45-degree field of view
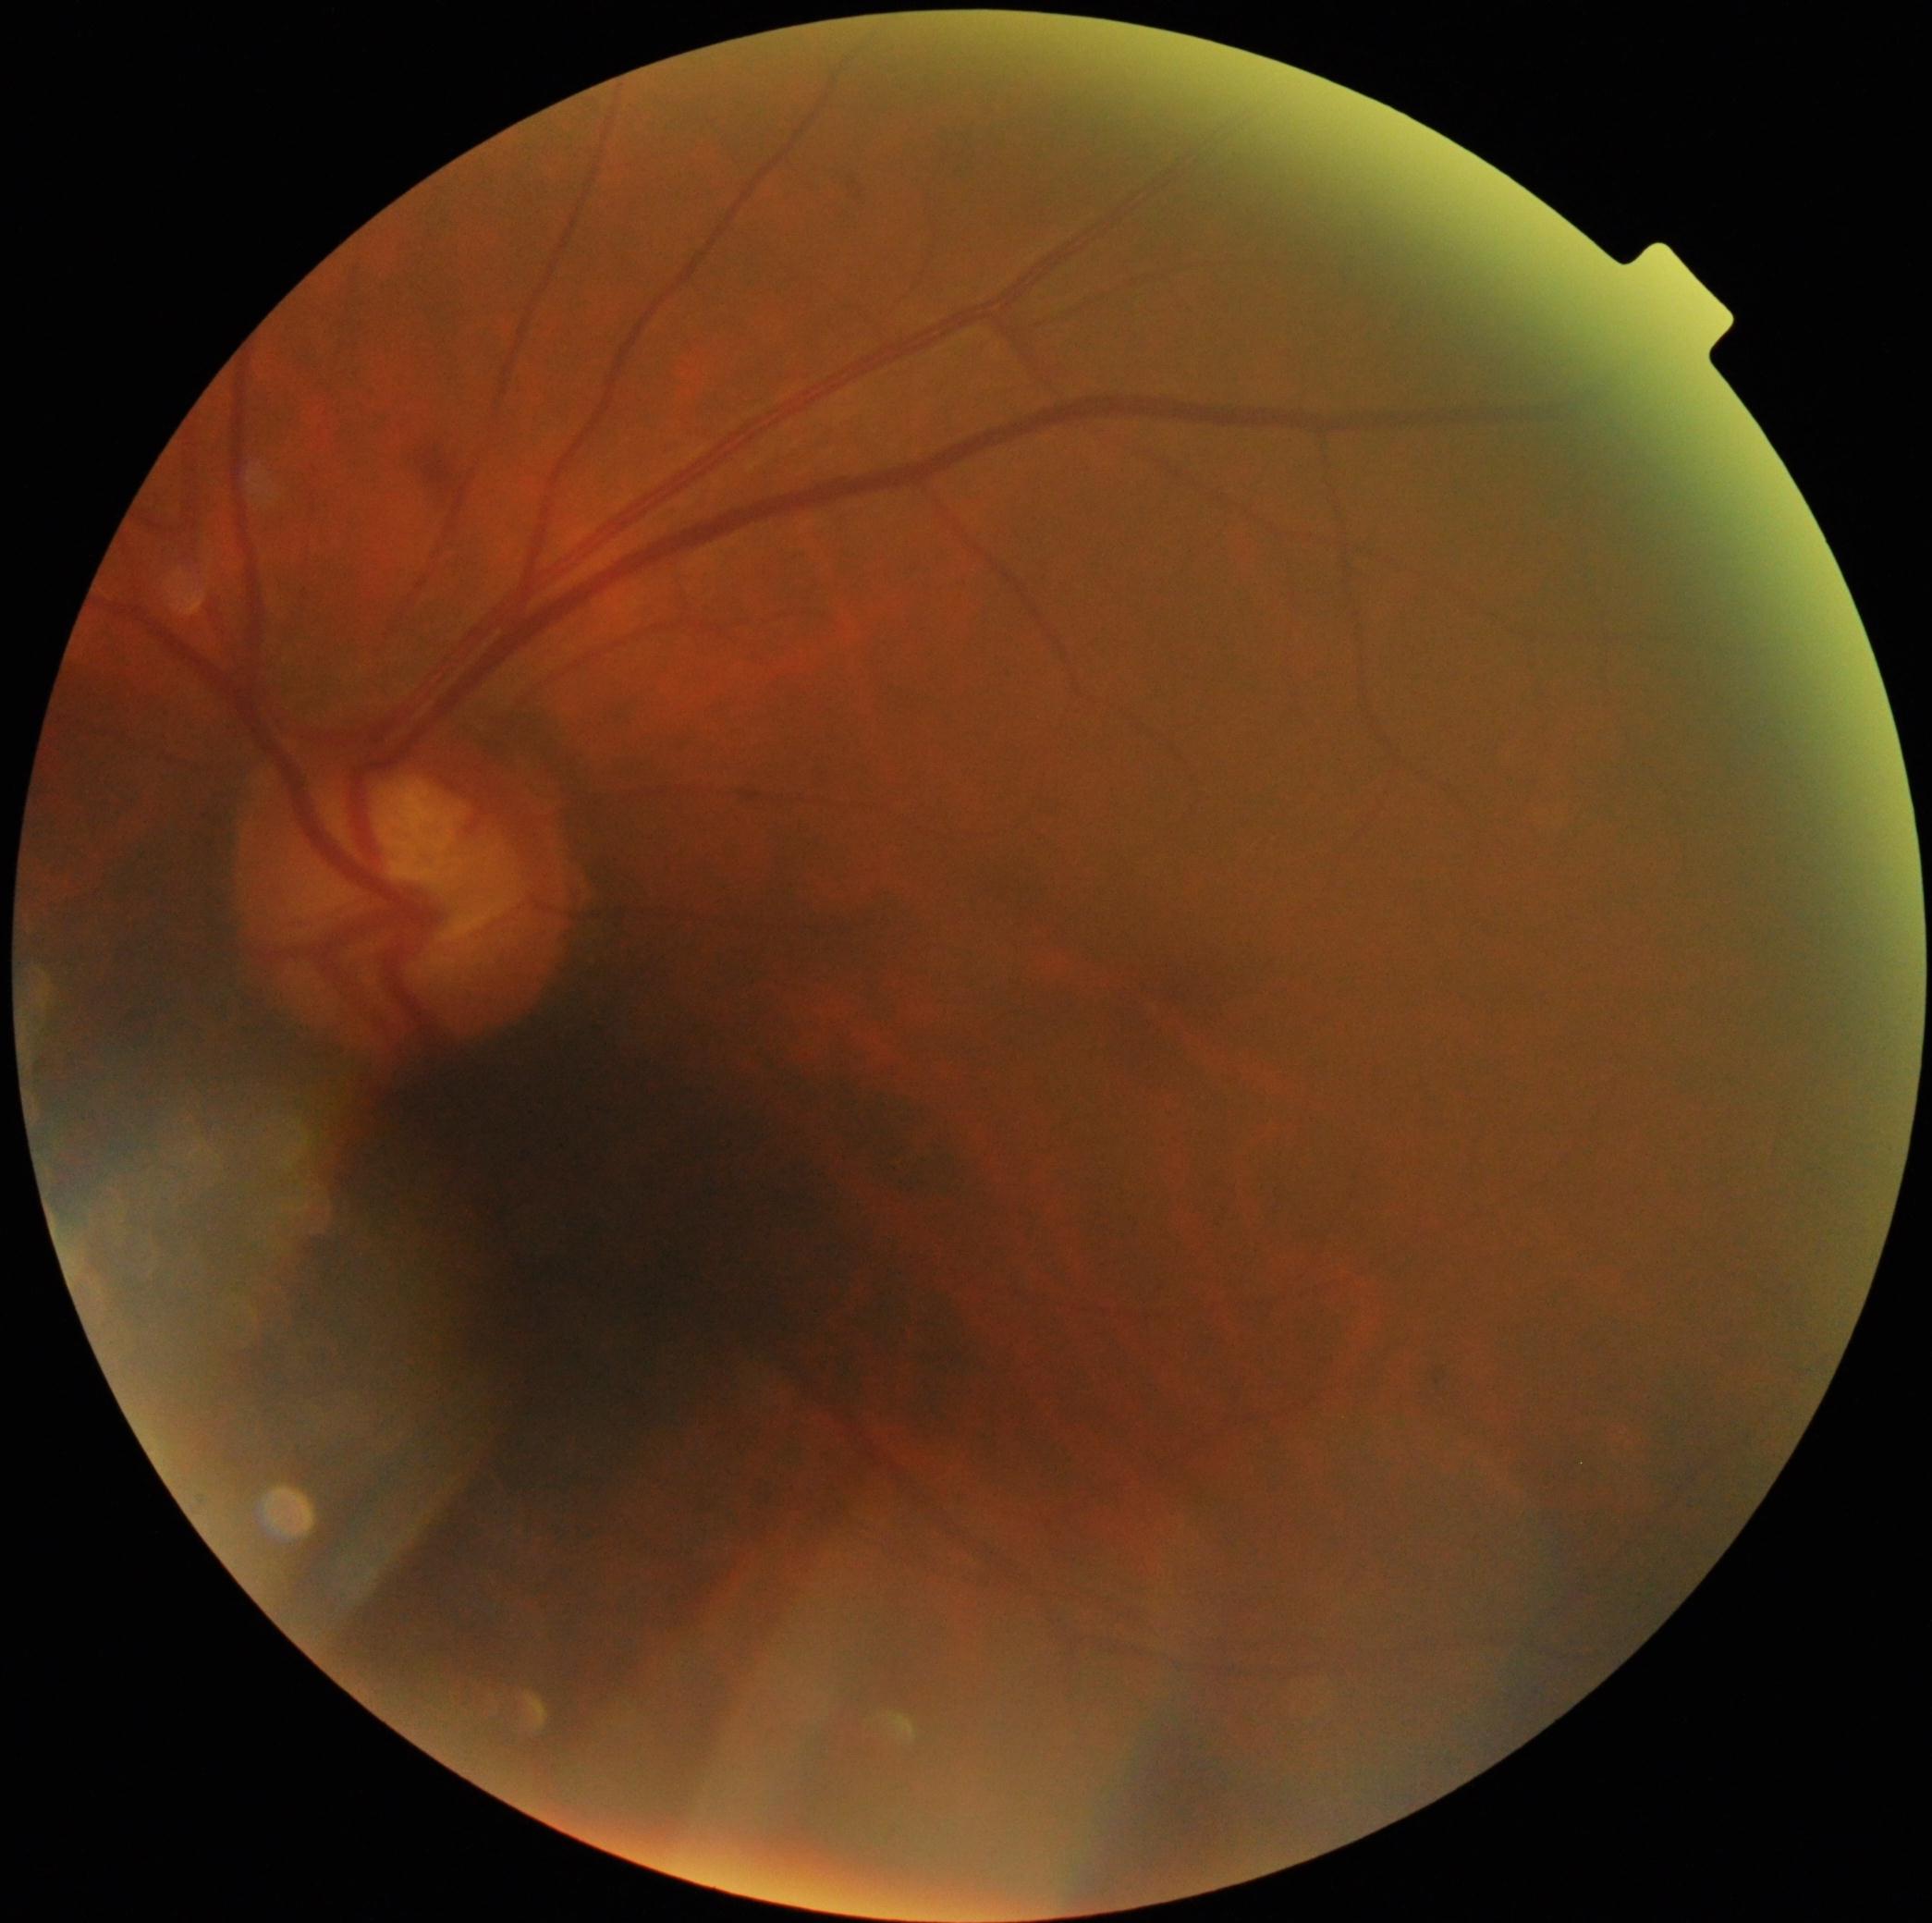

The retinopathy is classified as non-proliferative diabetic retinopathy. Diabetic retinopathy (DR): grade 2 (moderate NPDR) — more than just microaneurysms but less than severe NPDR.